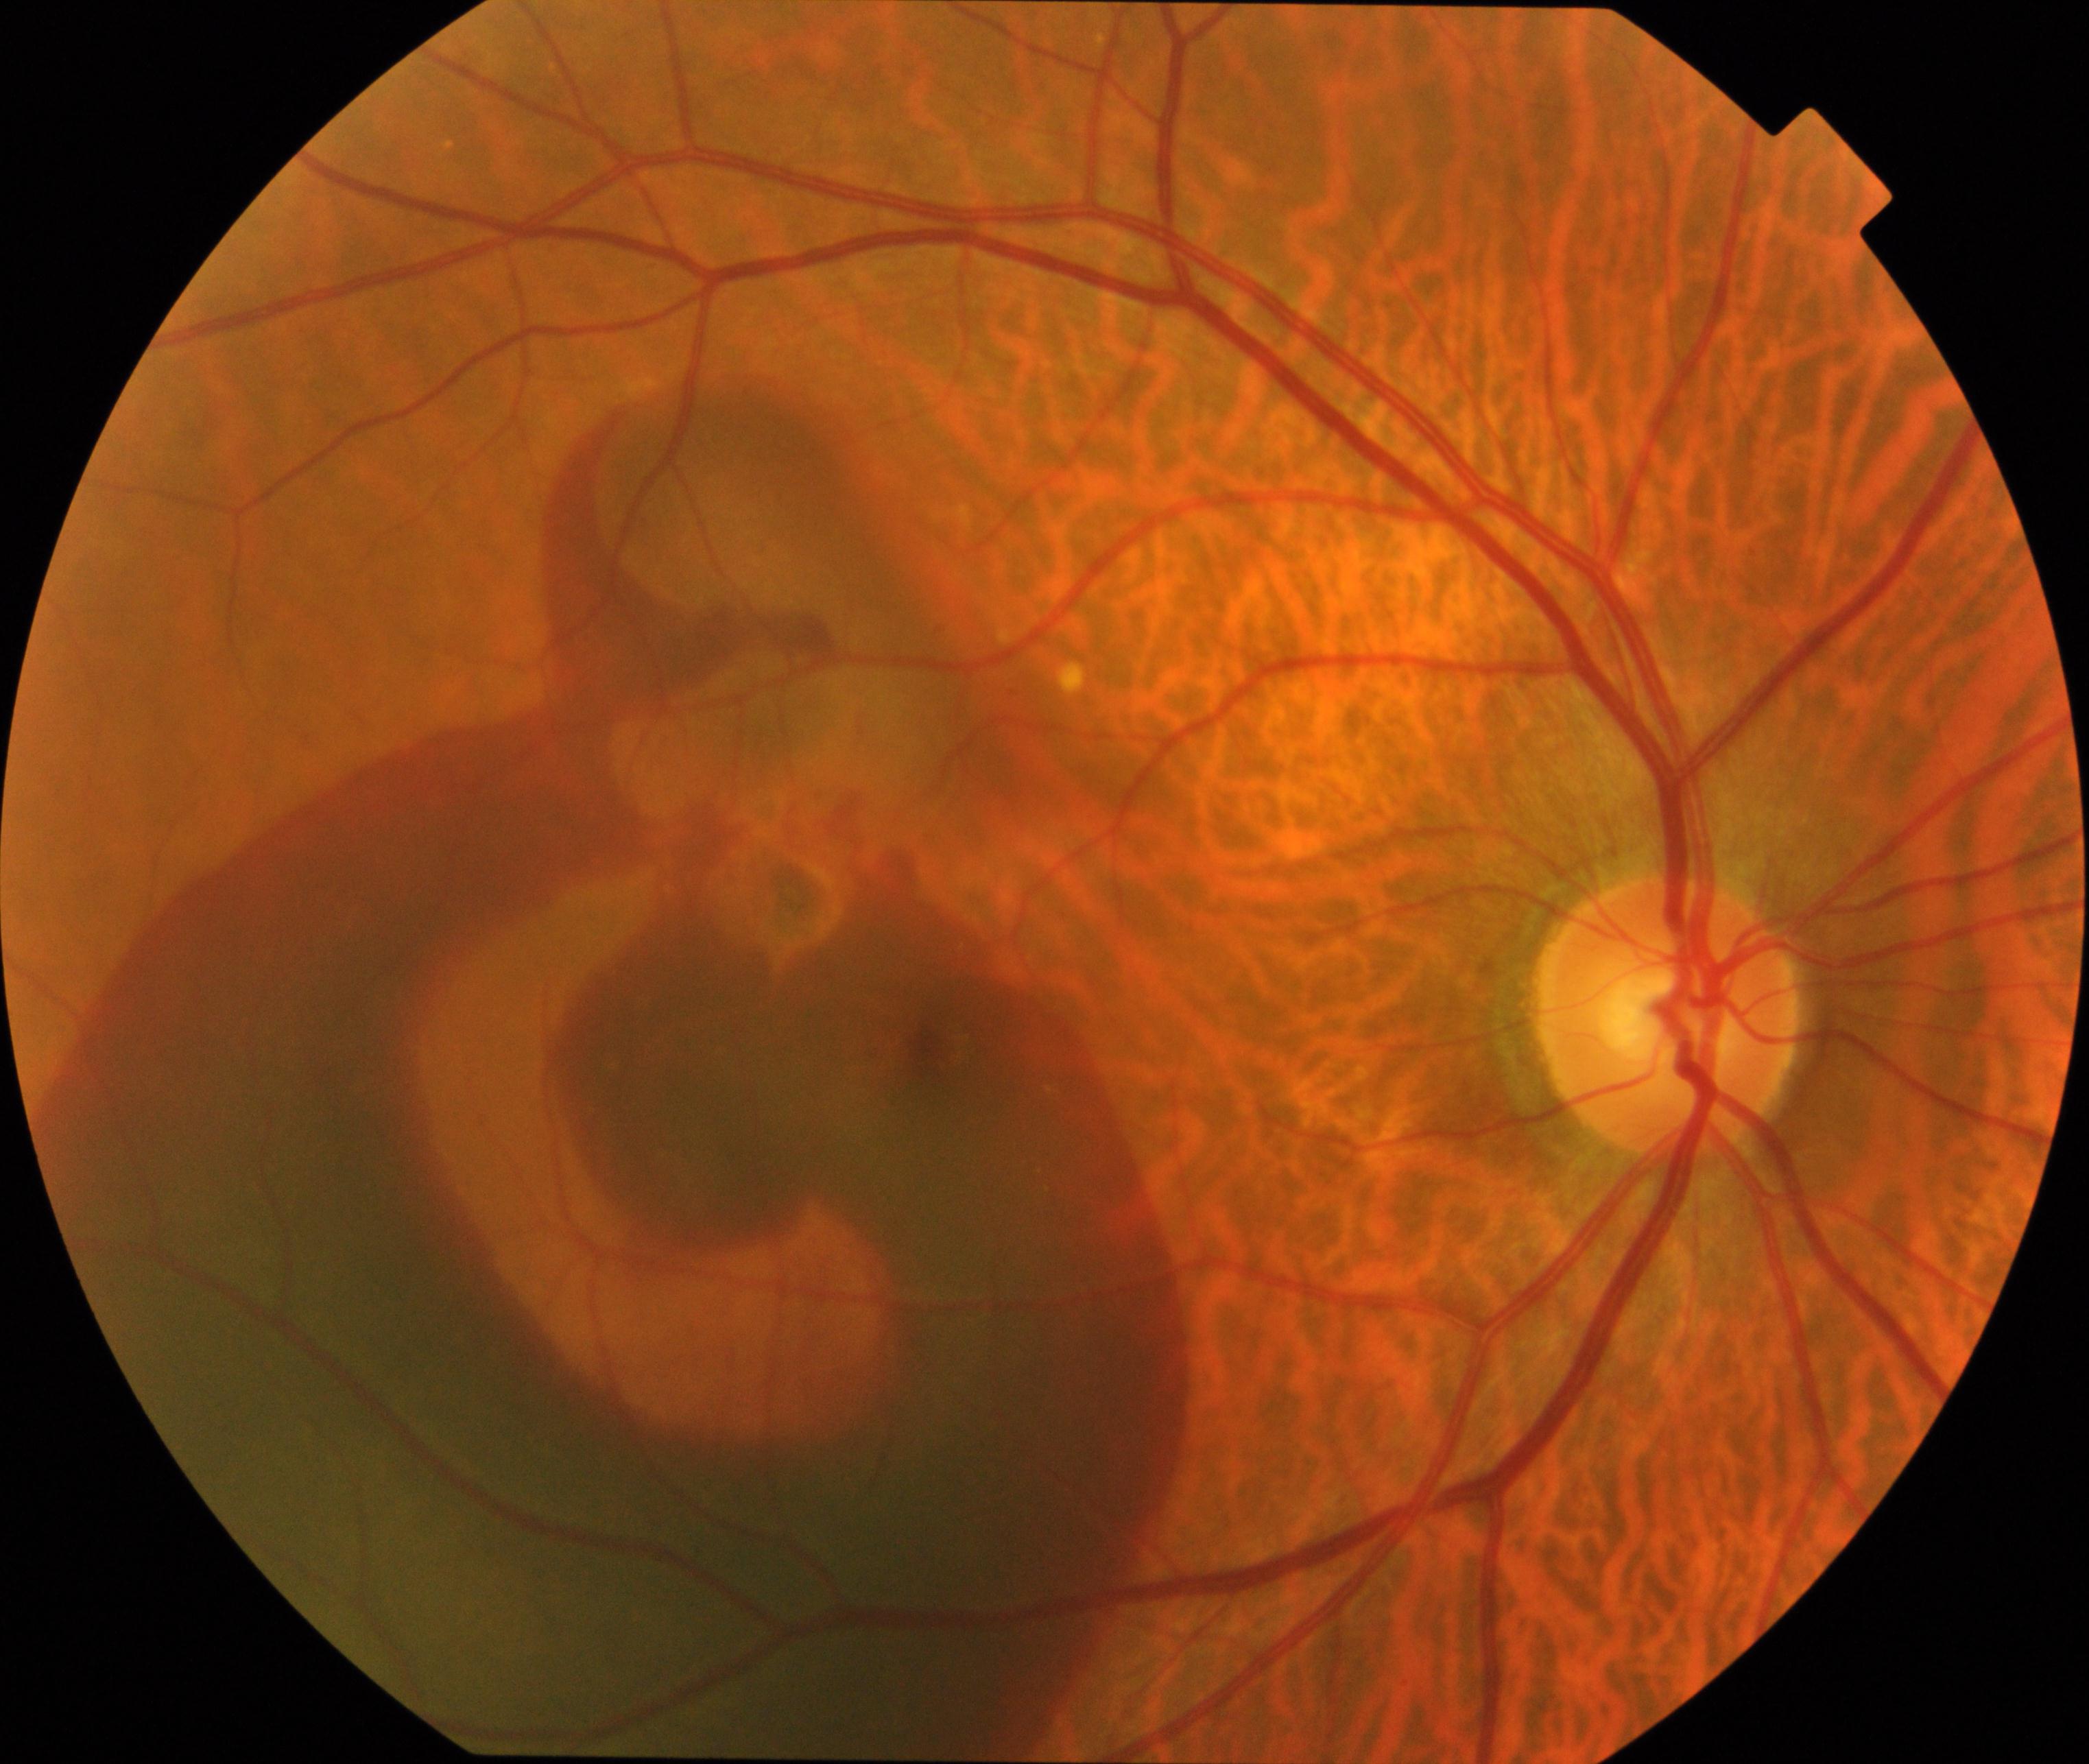

Primary finding: maculopathy.